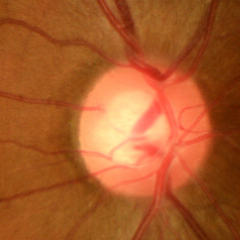
No evidence of glaucoma.